Acquired with a NIDEK AFC-230. 45° FOV:
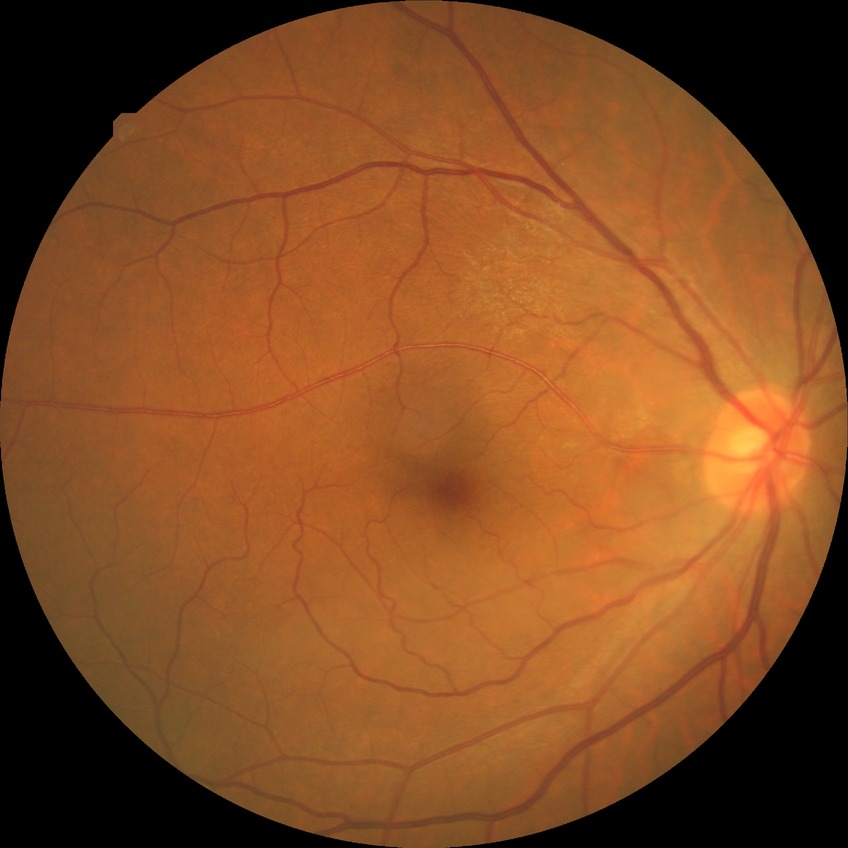
Annotations:
- diabetic retinopathy (DR) — NDR (no diabetic retinopathy)